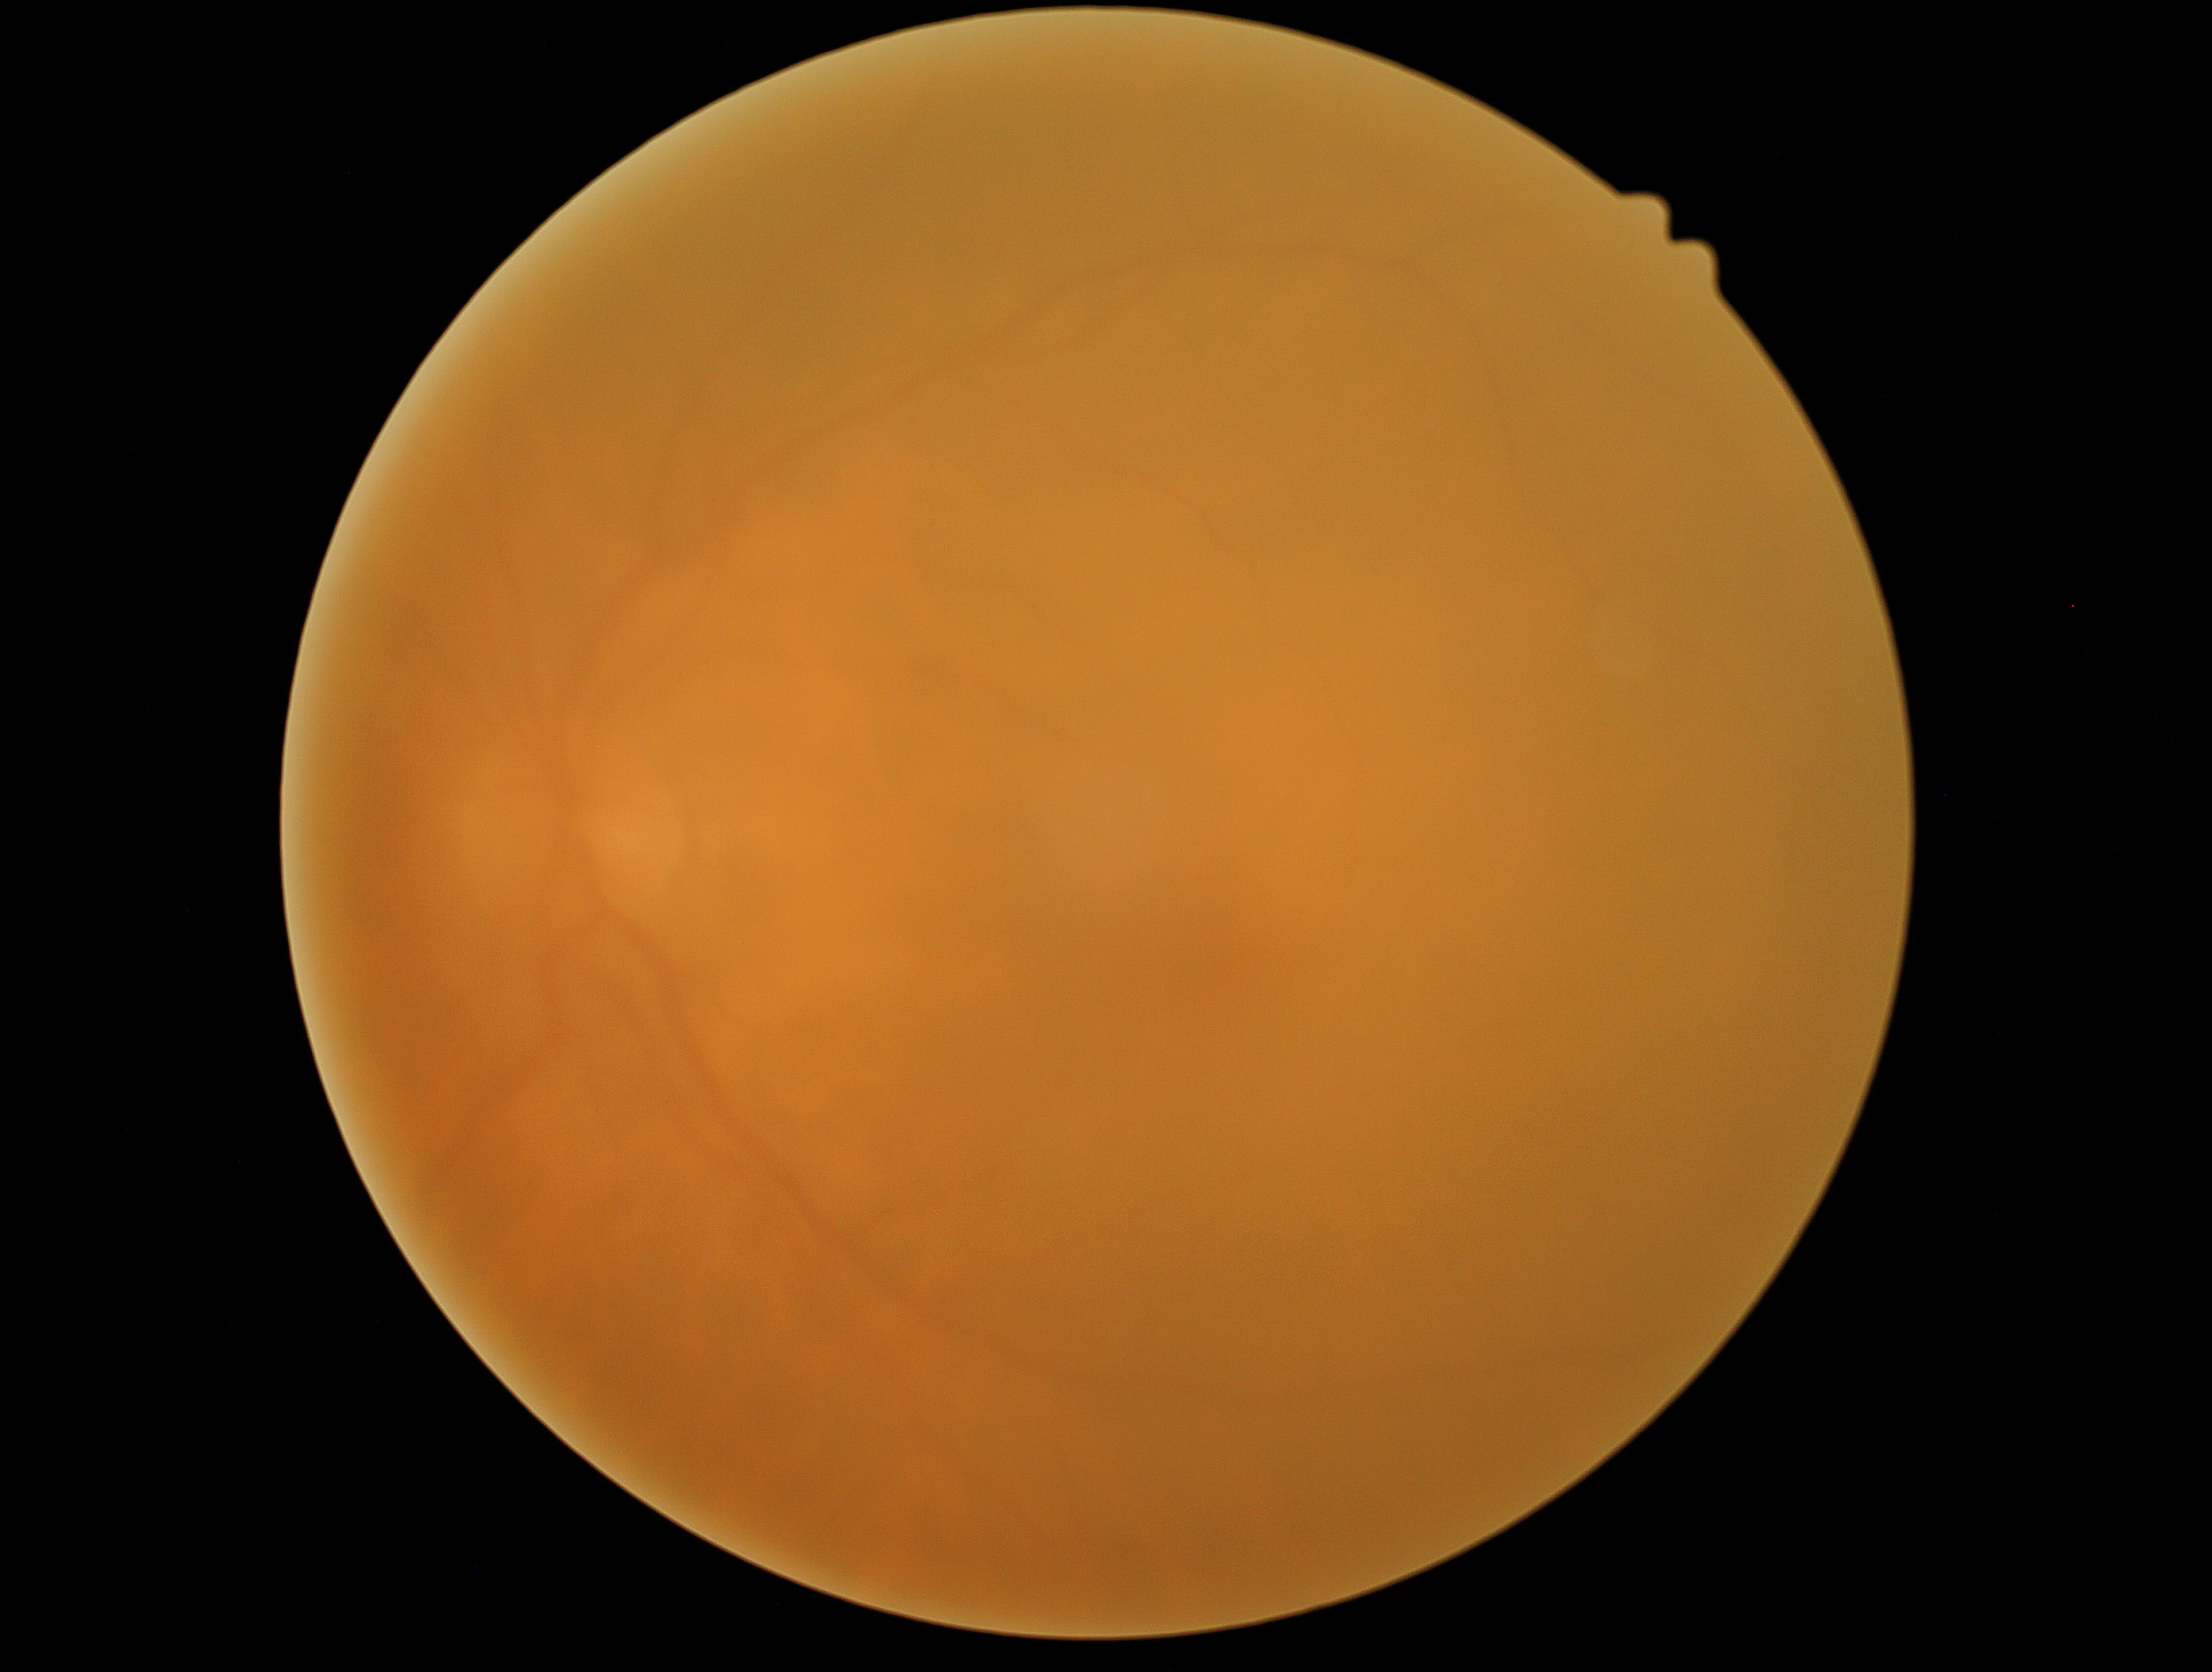 No DR findings. Diabetic retinopathy (DR) is 0/4.